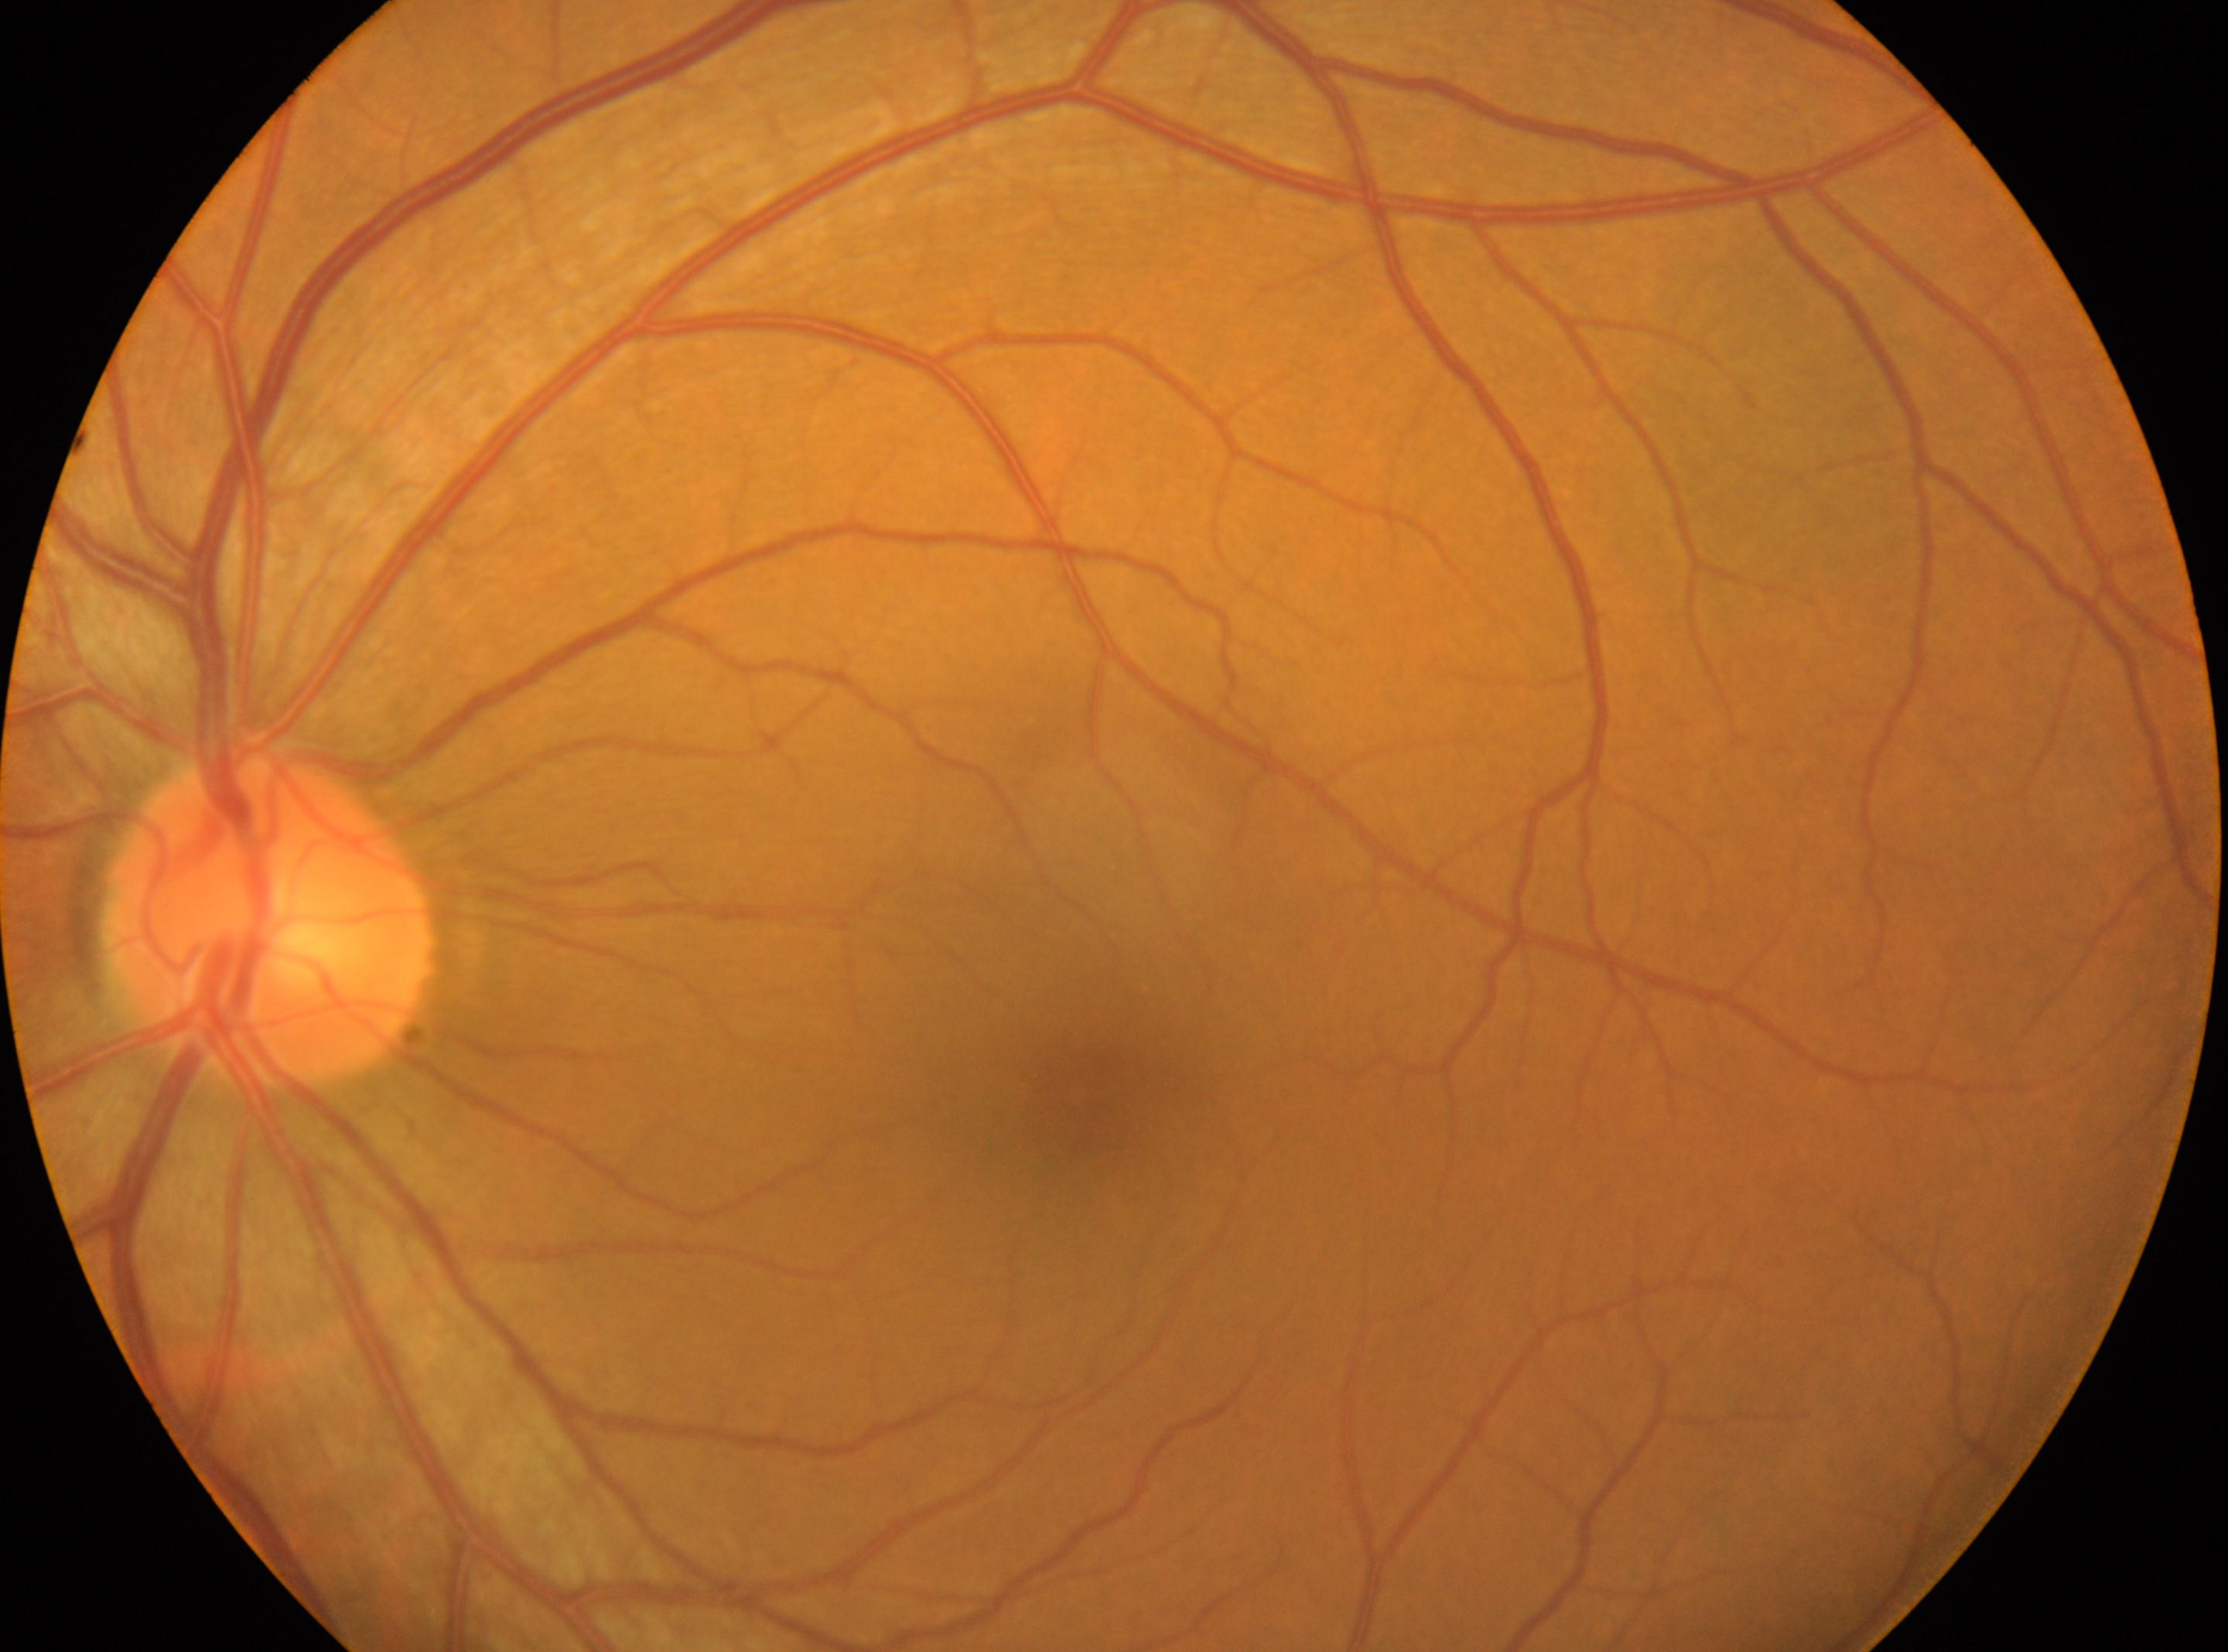

retinopathy grade: 0/4; left; No diabetic retinopathy identified; macular center: 1075, 1097; ONH: 271, 919.